Posterior pole color fundus photograph:
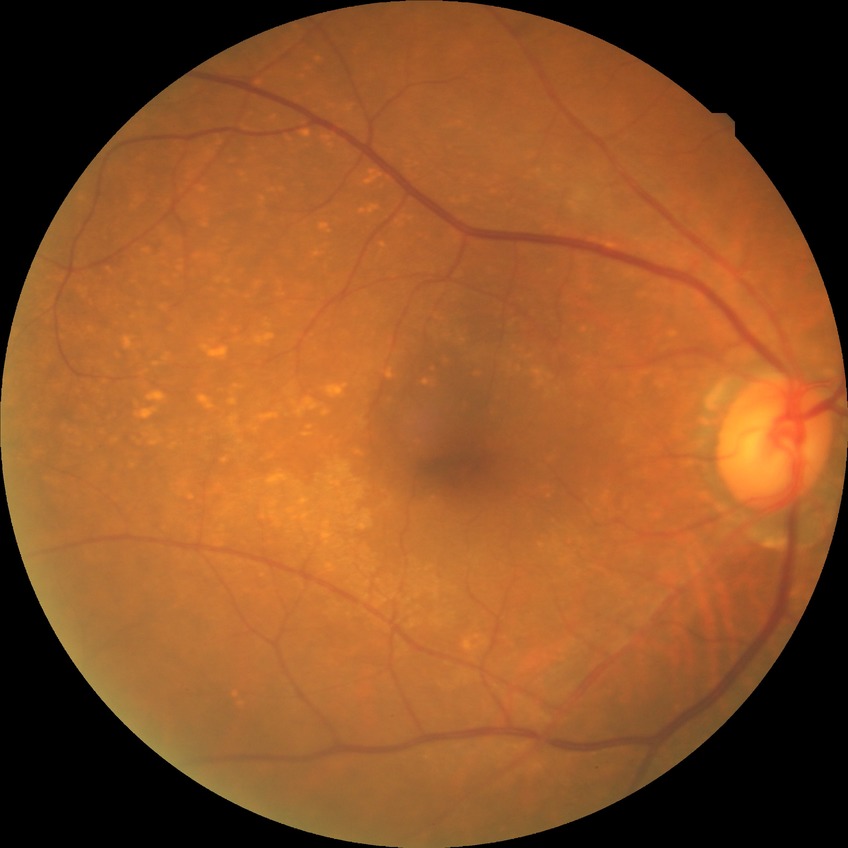 Modified Davis classification is no diabetic retinopathy.